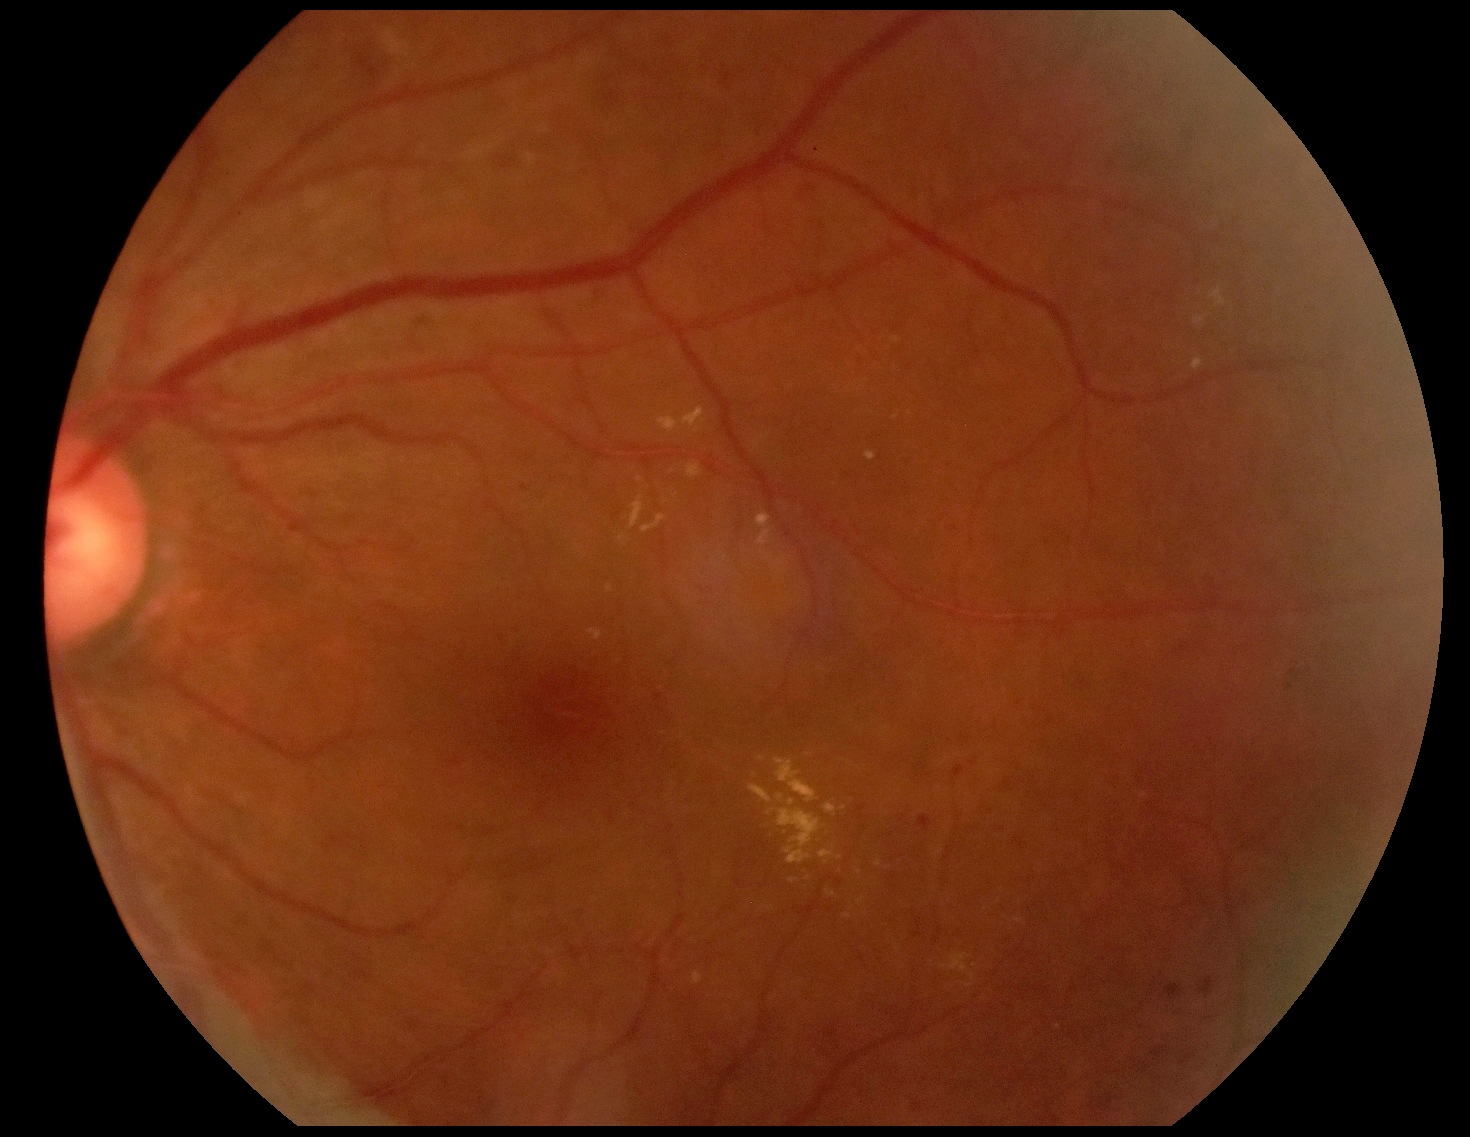
Diabetic retinopathy (DR): 2/4 — more than just microaneurysms but less than severe NPDR.